Modified Davis grading.
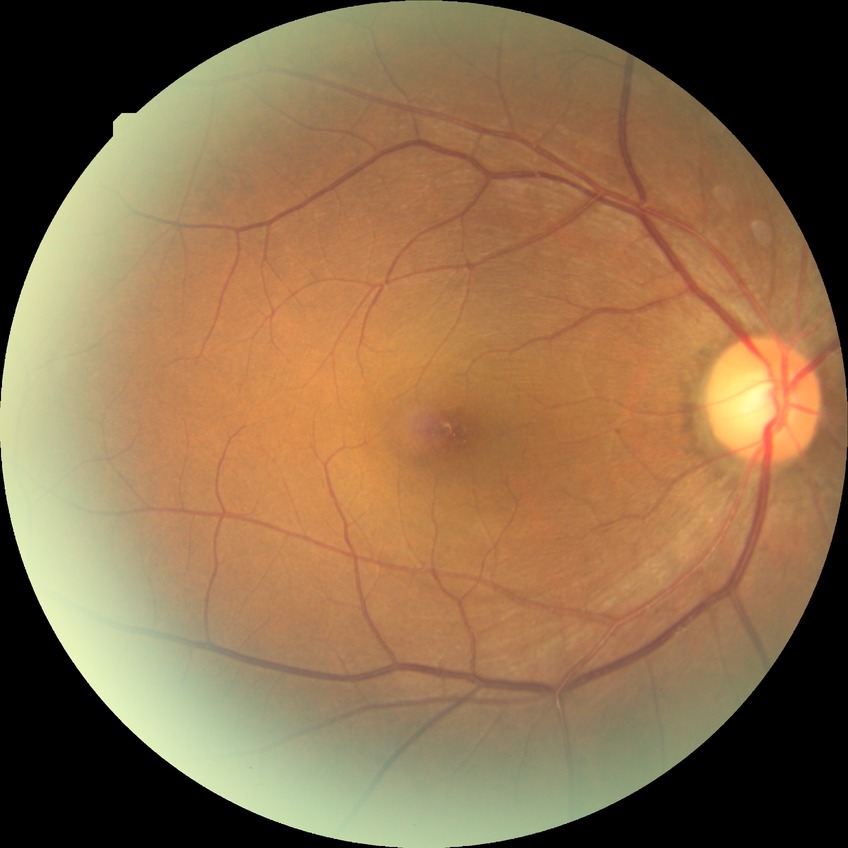 Diabetic retinopathy (DR) is NDR (no diabetic retinopathy).